Wide-field contact fundus photograph of an infant. 130° field of view (Natus RetCam Envision). Image size 1440x1080.
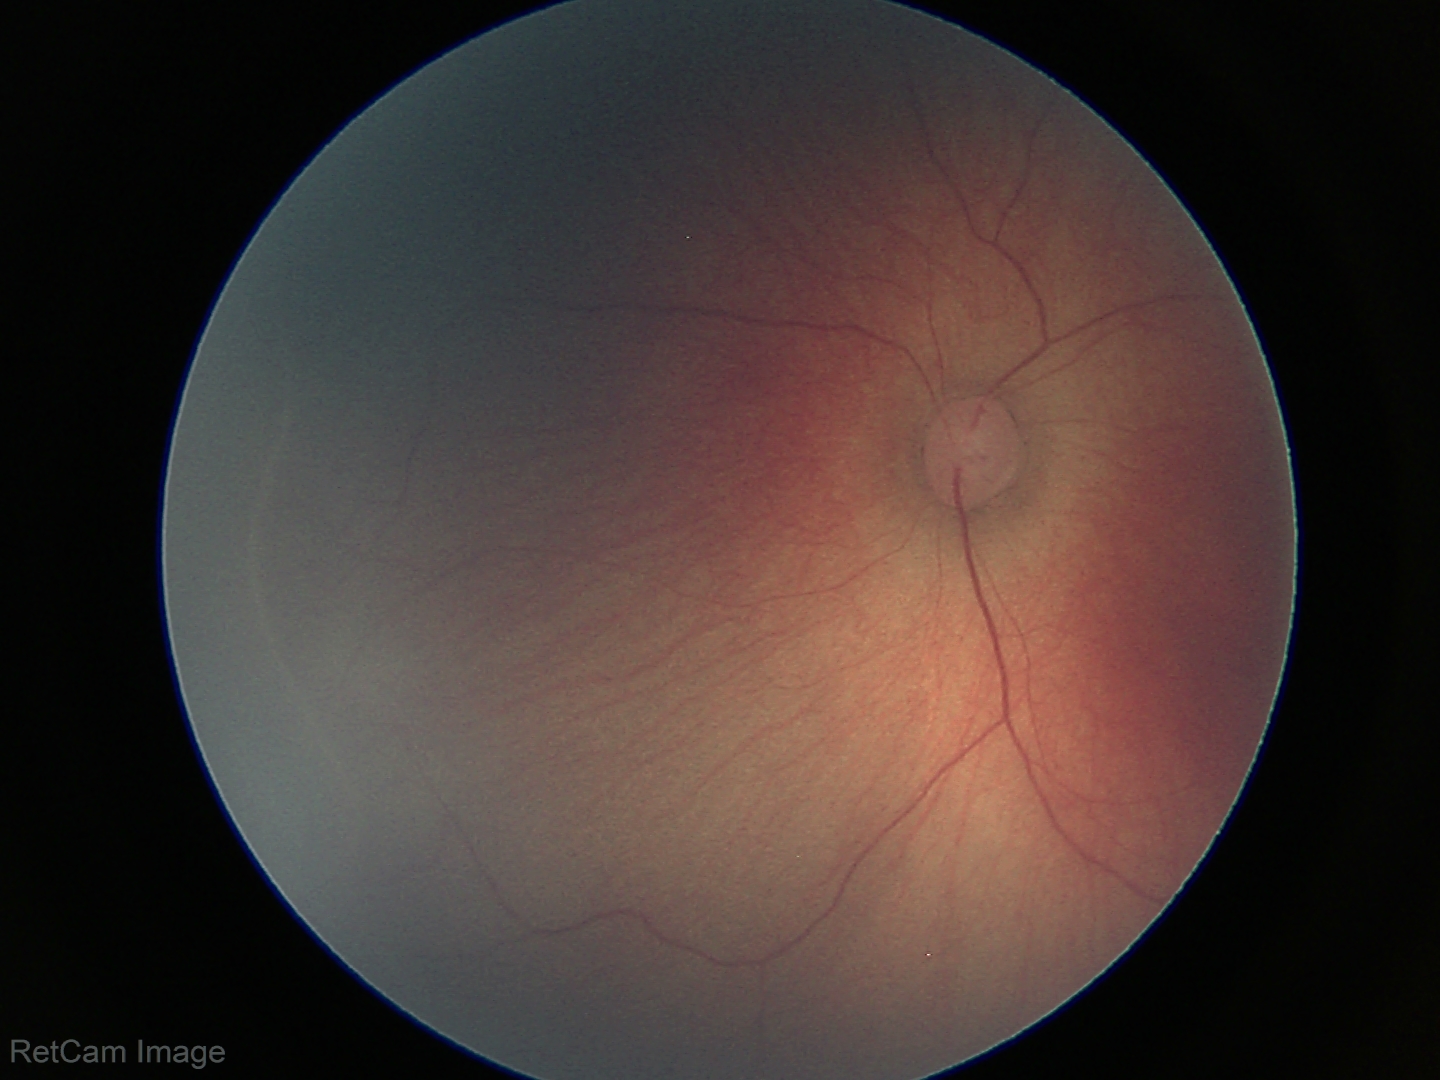
Examination diagnosed as retinopathy of prematurity stage 1.